Wide-field contact fundus photograph of an infant.
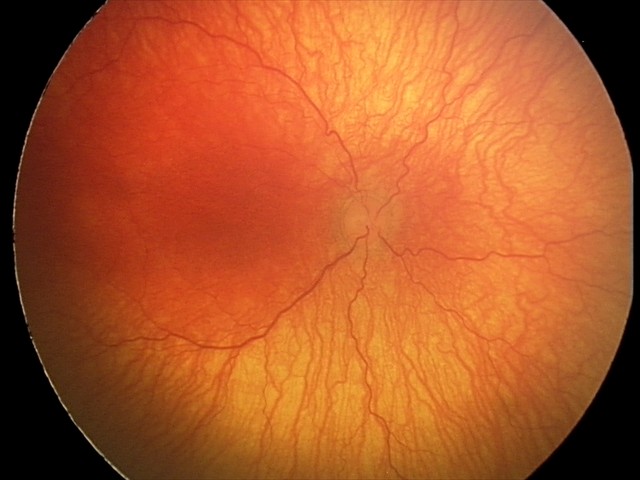 Screening diagnosis: aggressive ROP (A-ROP); plus disease.